Camera: NIDEK AFC-230, 848x848px.
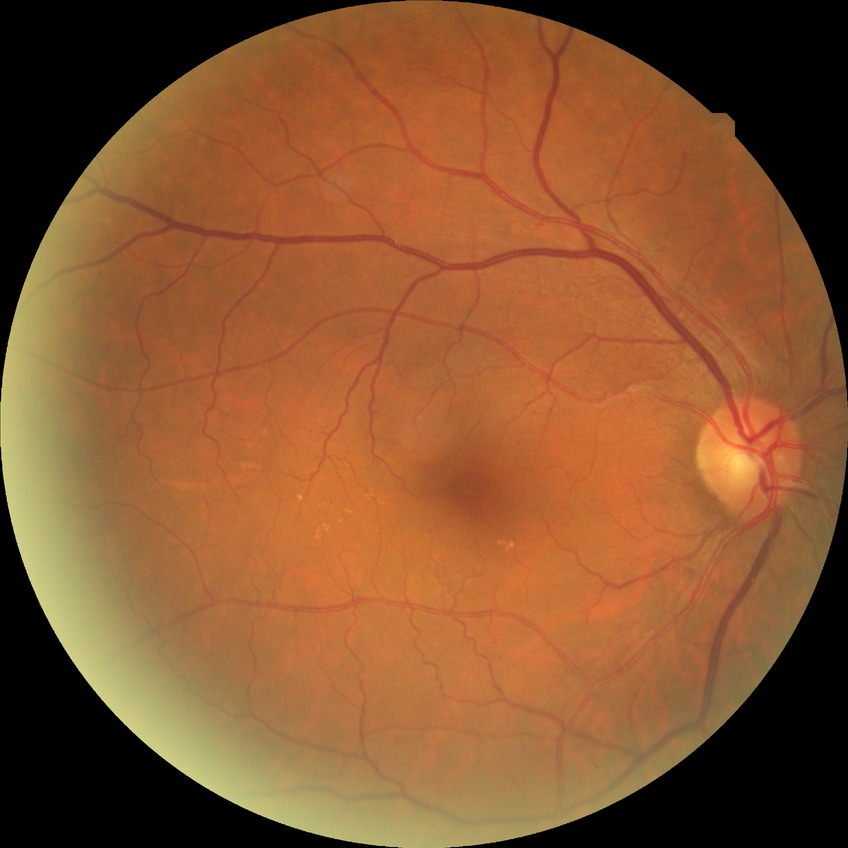

{"dr_impression": "no apparent DR", "davis_grade": "NDR"}